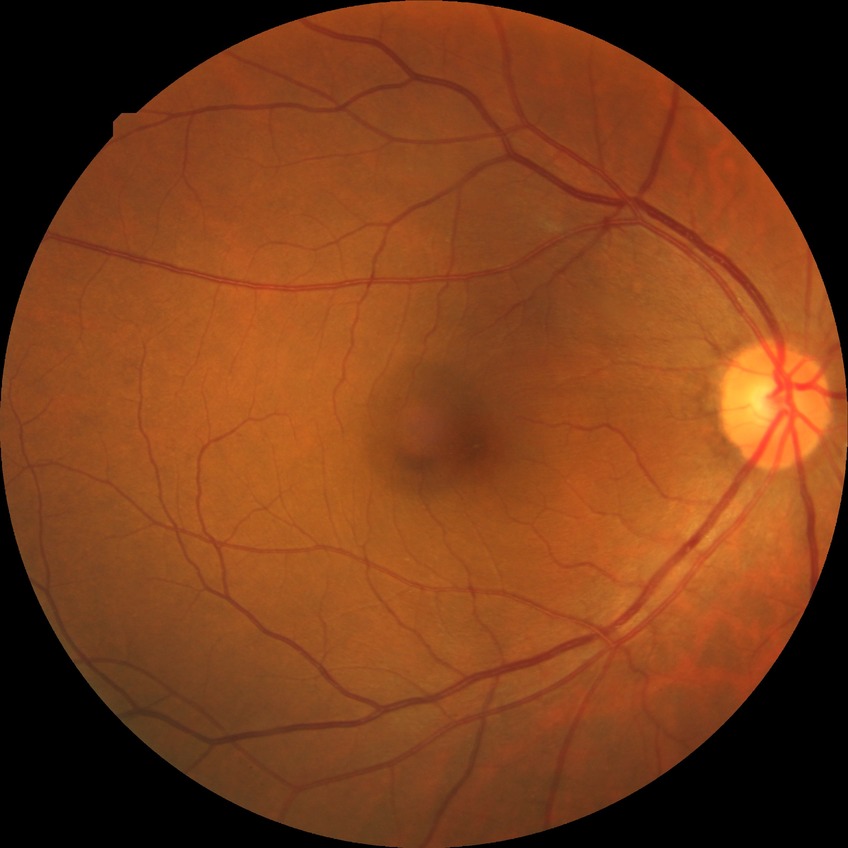
diabetic retinopathy (DR)@no diabetic retinopathy (NDR).